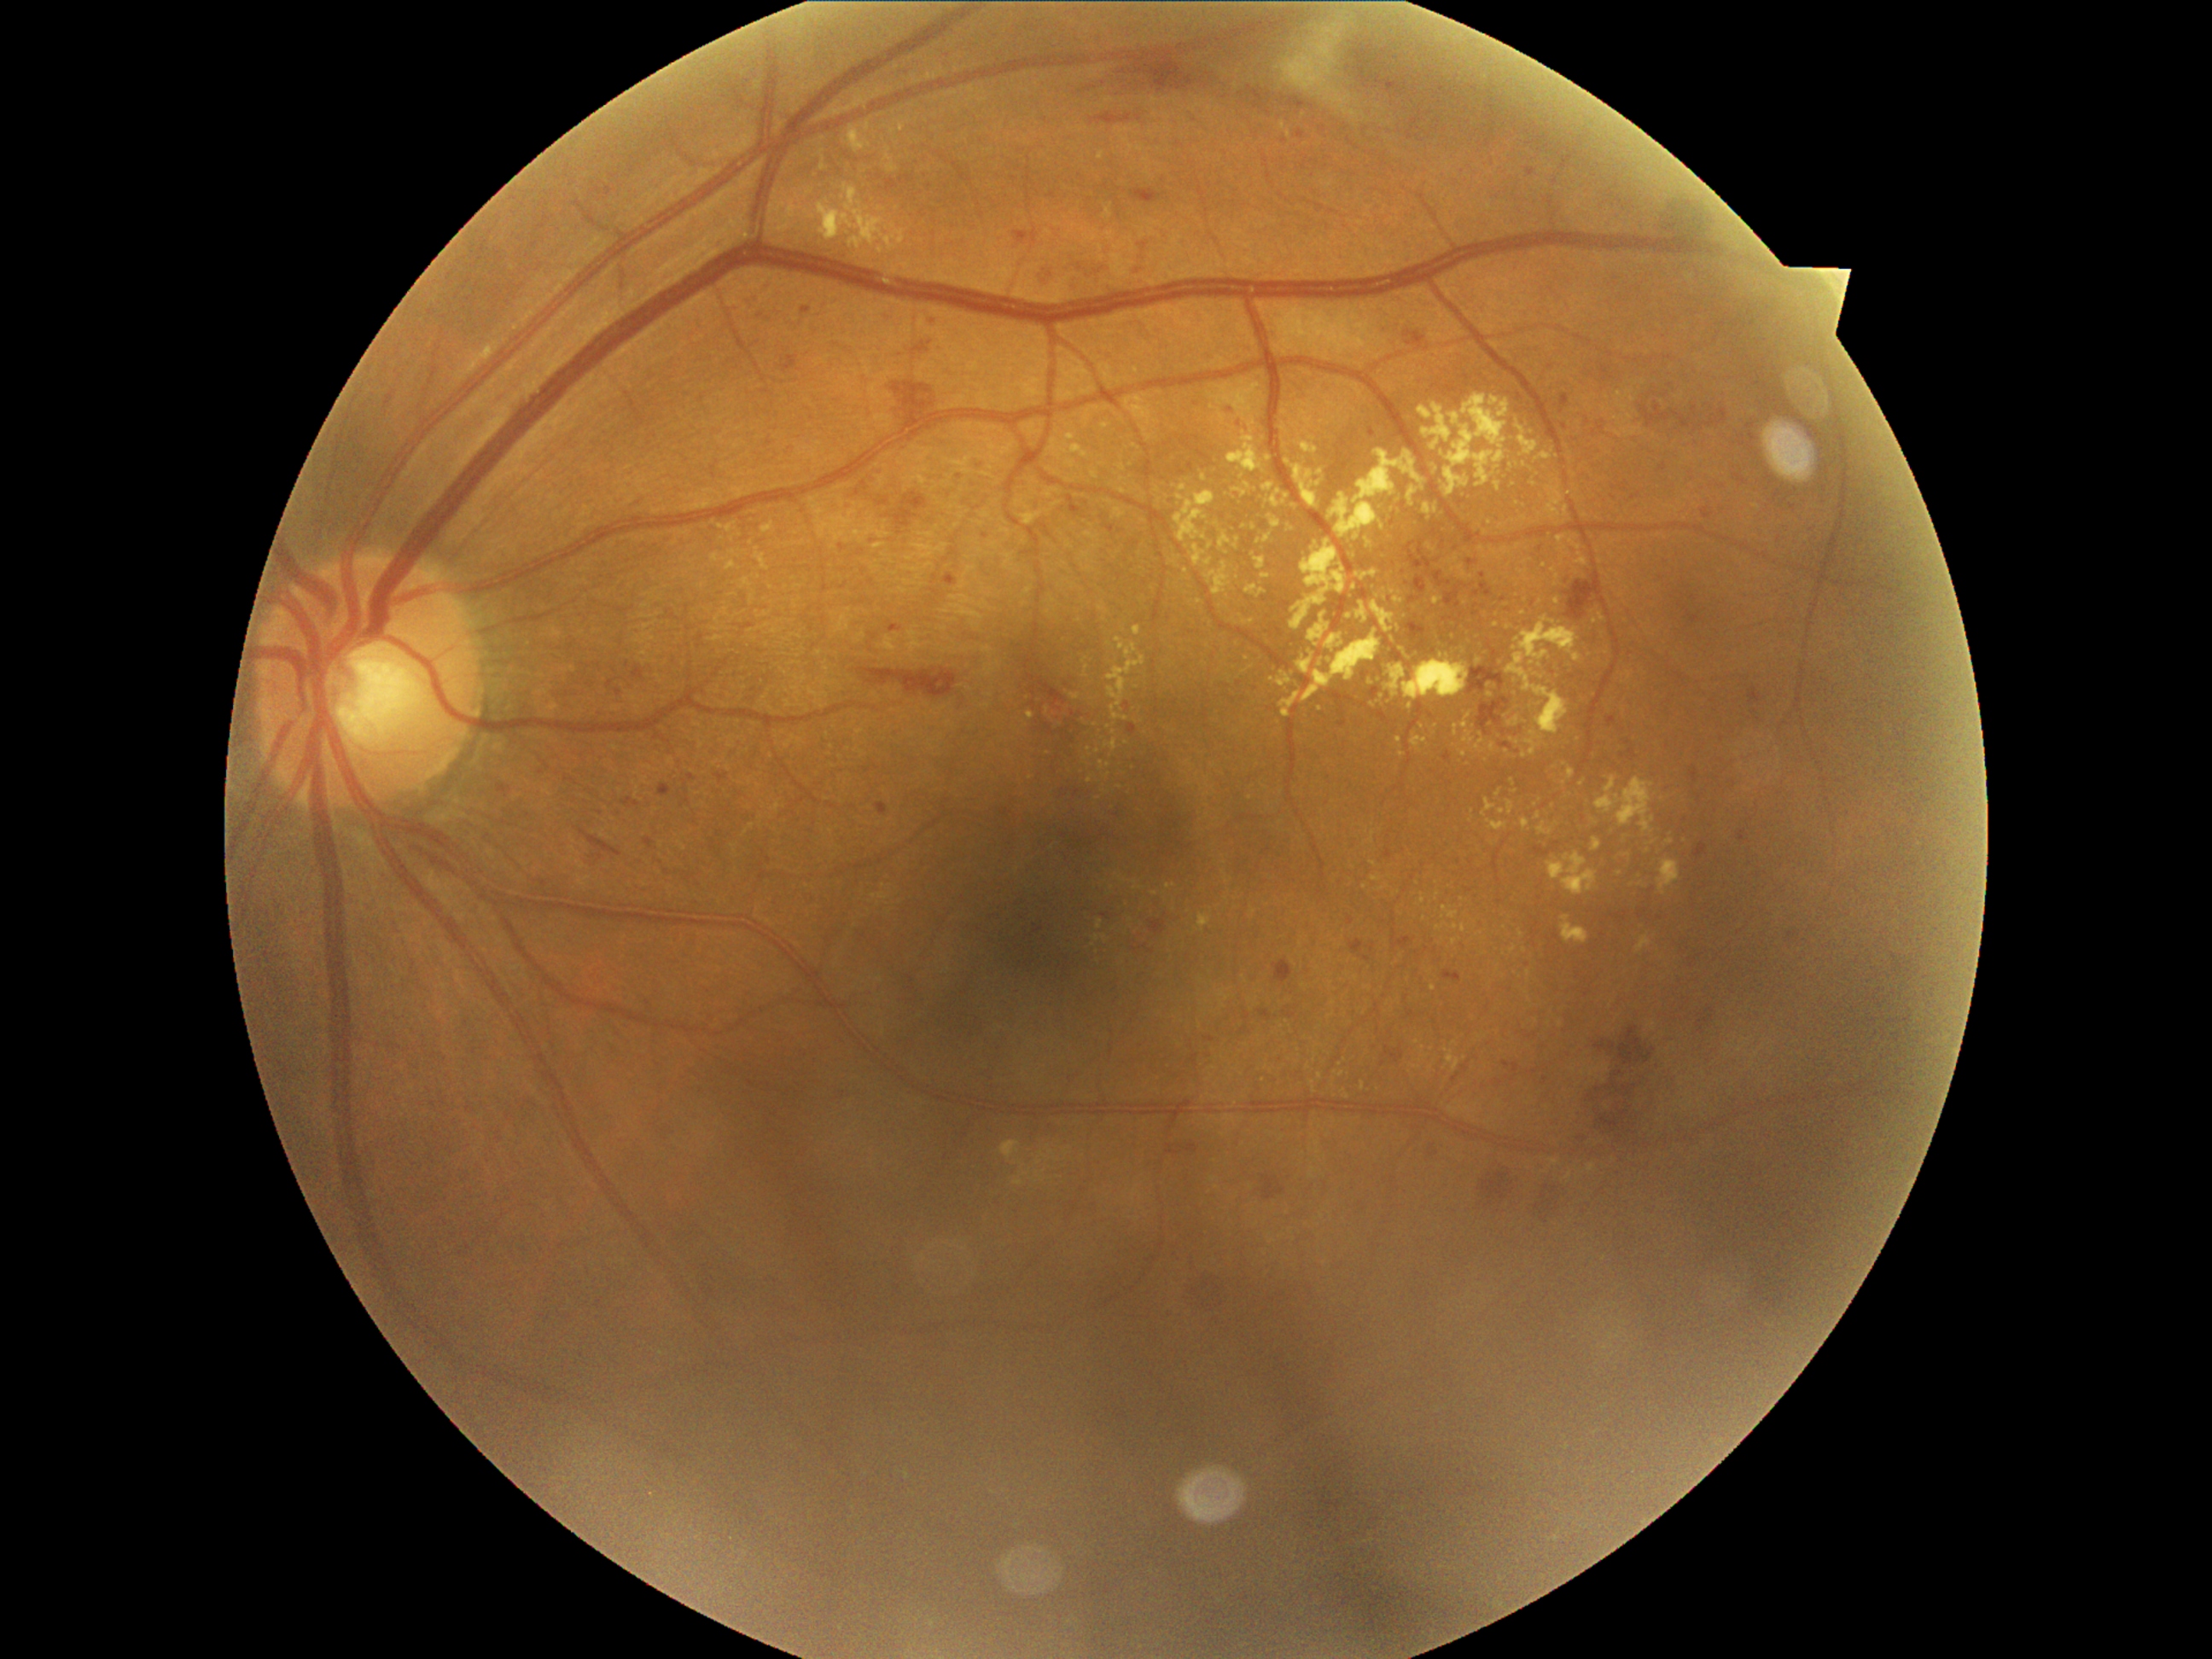 <lesions partial="true">
  <dr_grade>2</dr_grade>
  <ex partial="true">x1=1667 y1=839 x2=1675 y2=846, x1=1631 y1=878 x2=1638 y2=888, x1=1228 y1=434 x2=1264 y2=474, x1=1318 y1=660 x2=1324 y2=668, x1=1417 y1=405 x2=1435 y2=421, x1=1100 y1=762 x2=1110 y2=771, x1=1614 y1=849 x2=1627 y2=864, x1=1262 y1=484 x2=1276 y2=492, x1=728 y1=561 x2=736 y2=569, x1=1192 y1=544 x2=1213 y2=568</ex>
  <ex_small_centers><pt>1779,769</pt>, <pt>1315,1092</pt>, <pt>1455,928</pt>, <pt>1247,659</pt>, <pt>1111,645</pt>, <pt>1602,562</pt>, <pt>1582,785</pt>, <pt>1409,706</pt>, <pt>1481,934</pt></ex_small_centers>
</lesions>